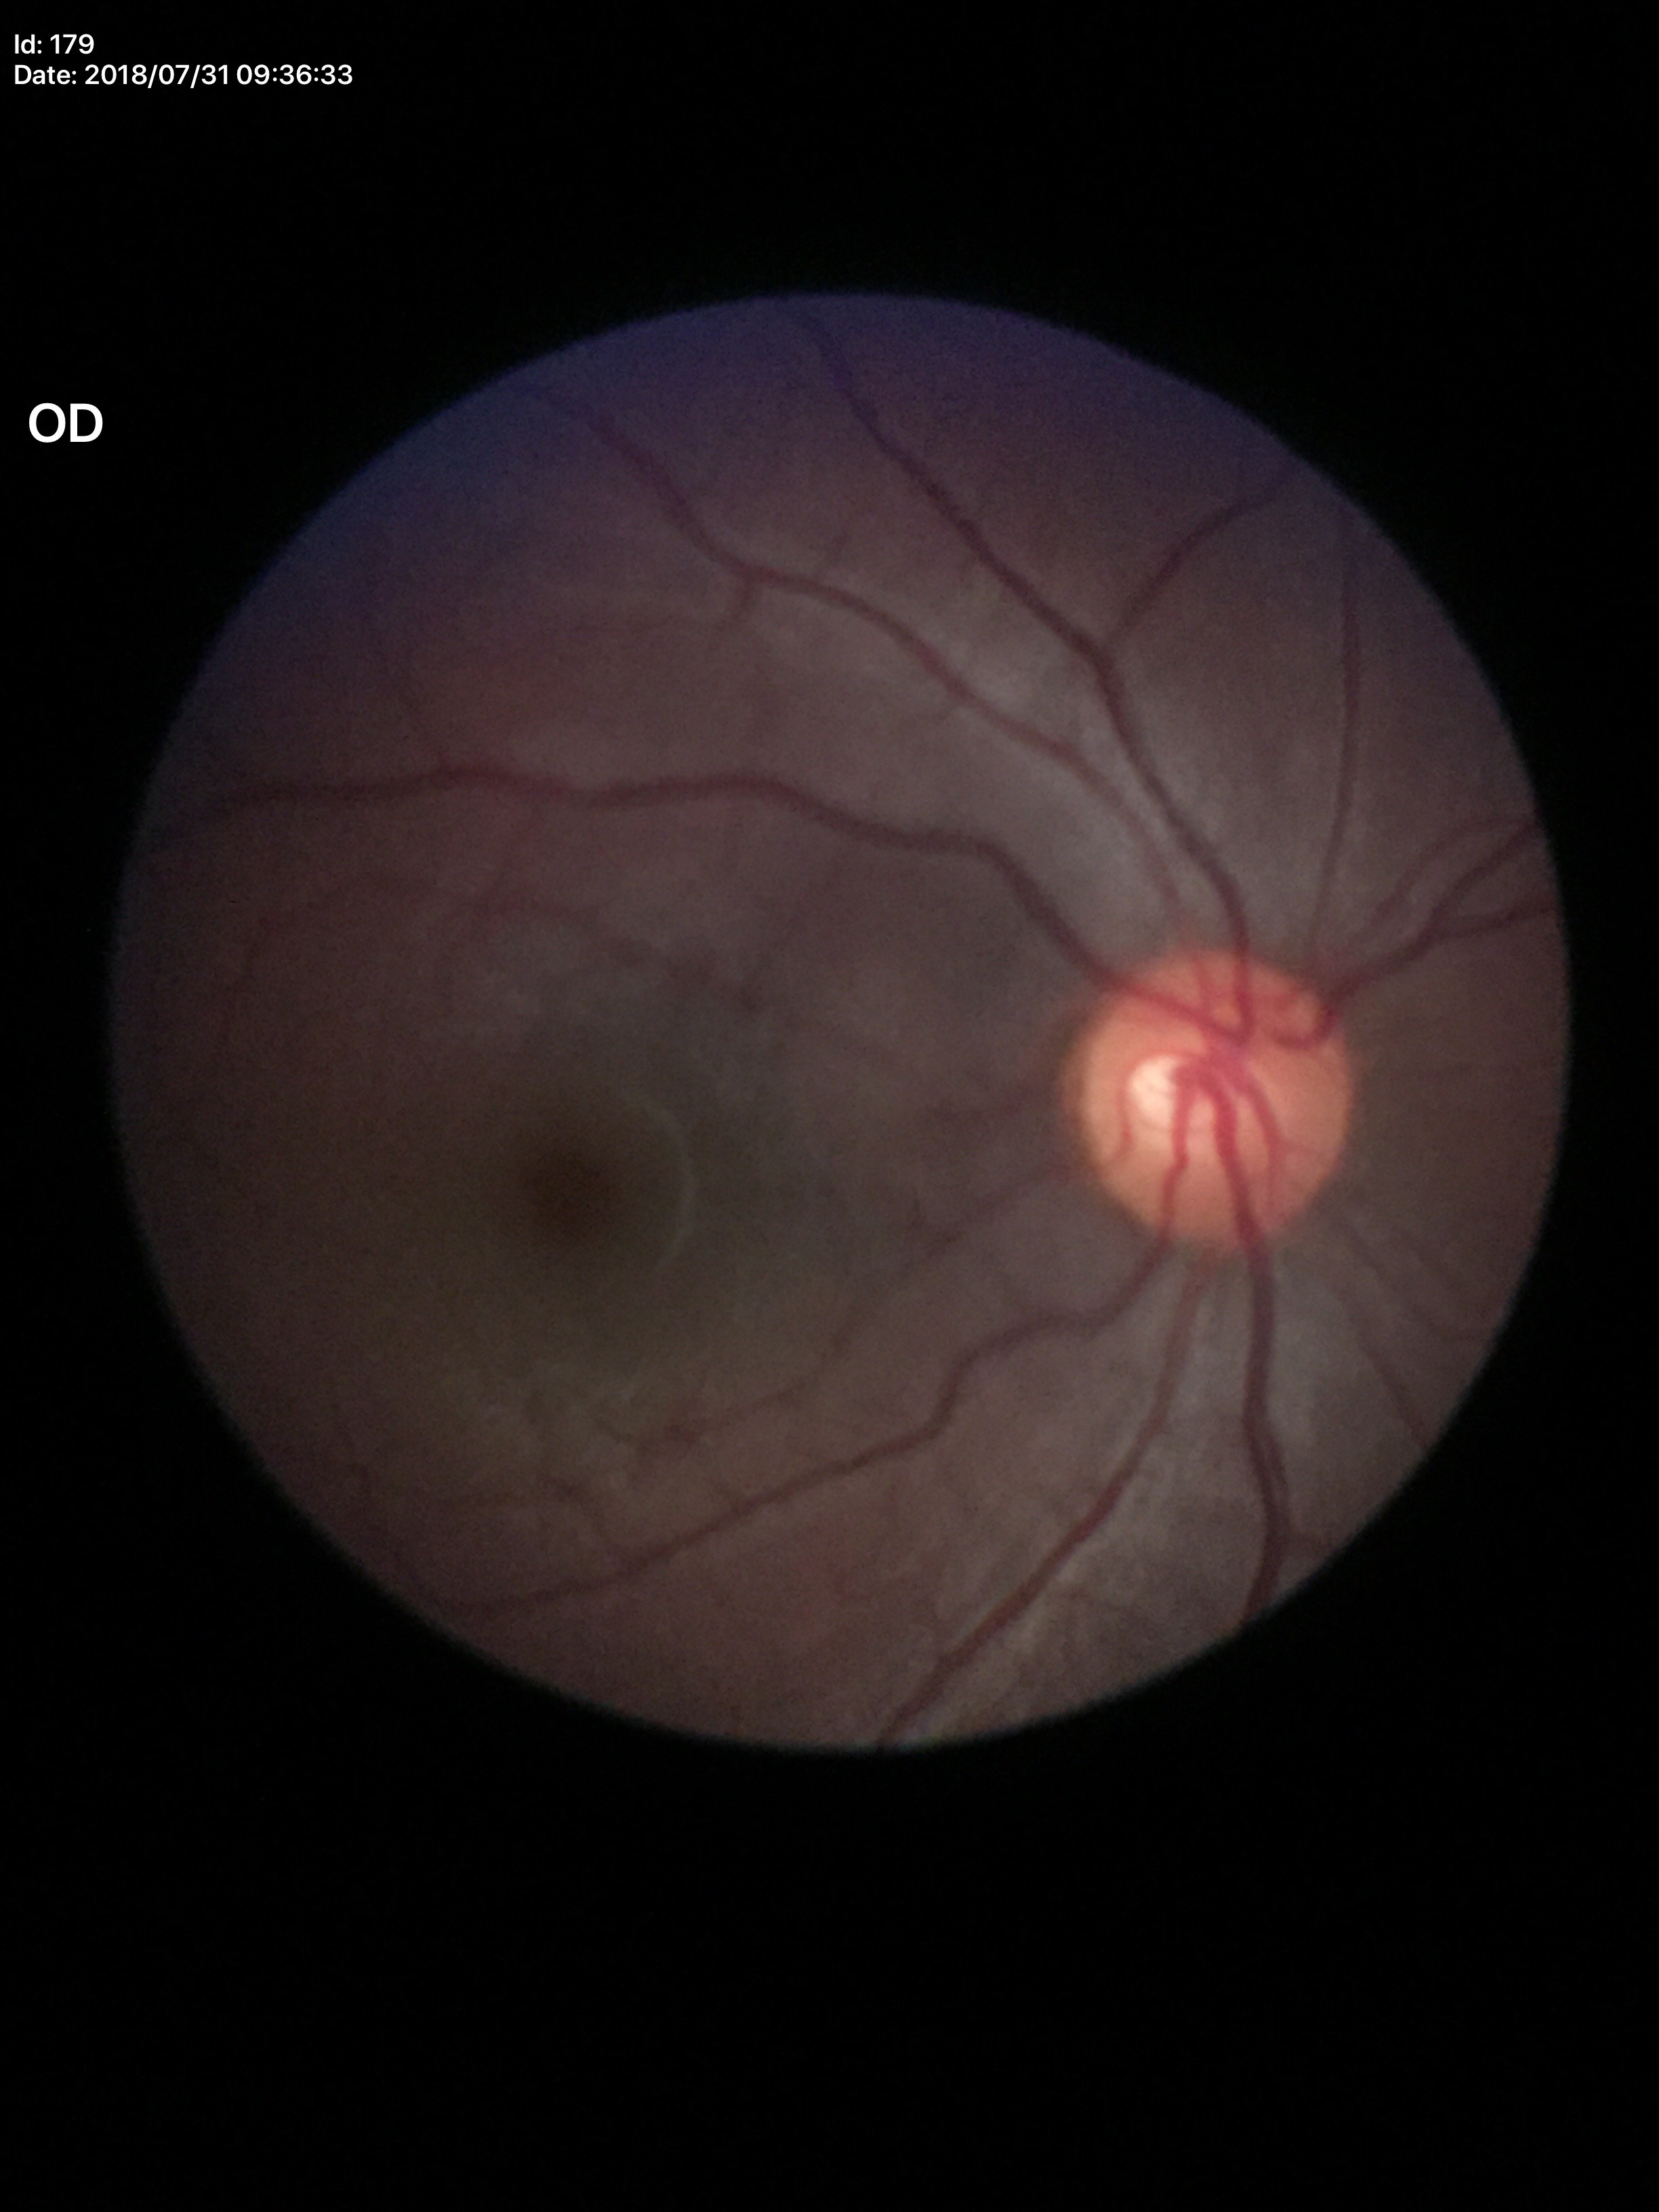
No glaucomatous findings (all 5 graders called normal). Vertical cup-disc ratio of 0.50. Horizontal cup-to-disc ratio is 0.55.